Wide-field fundus photograph of an infant · image size 640x480 — 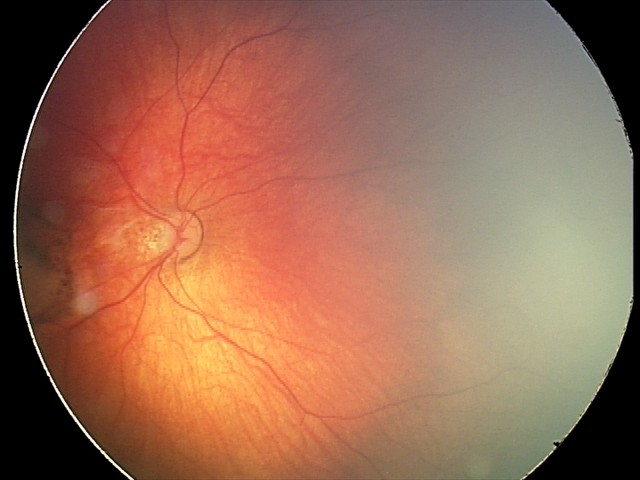

Screening diagnosis = toxoplasmosis chorioretinitis